Captured after pupil dilation; macula-centered; 50° FOV; camera: Kowa VX-10α; 2361x1568px: 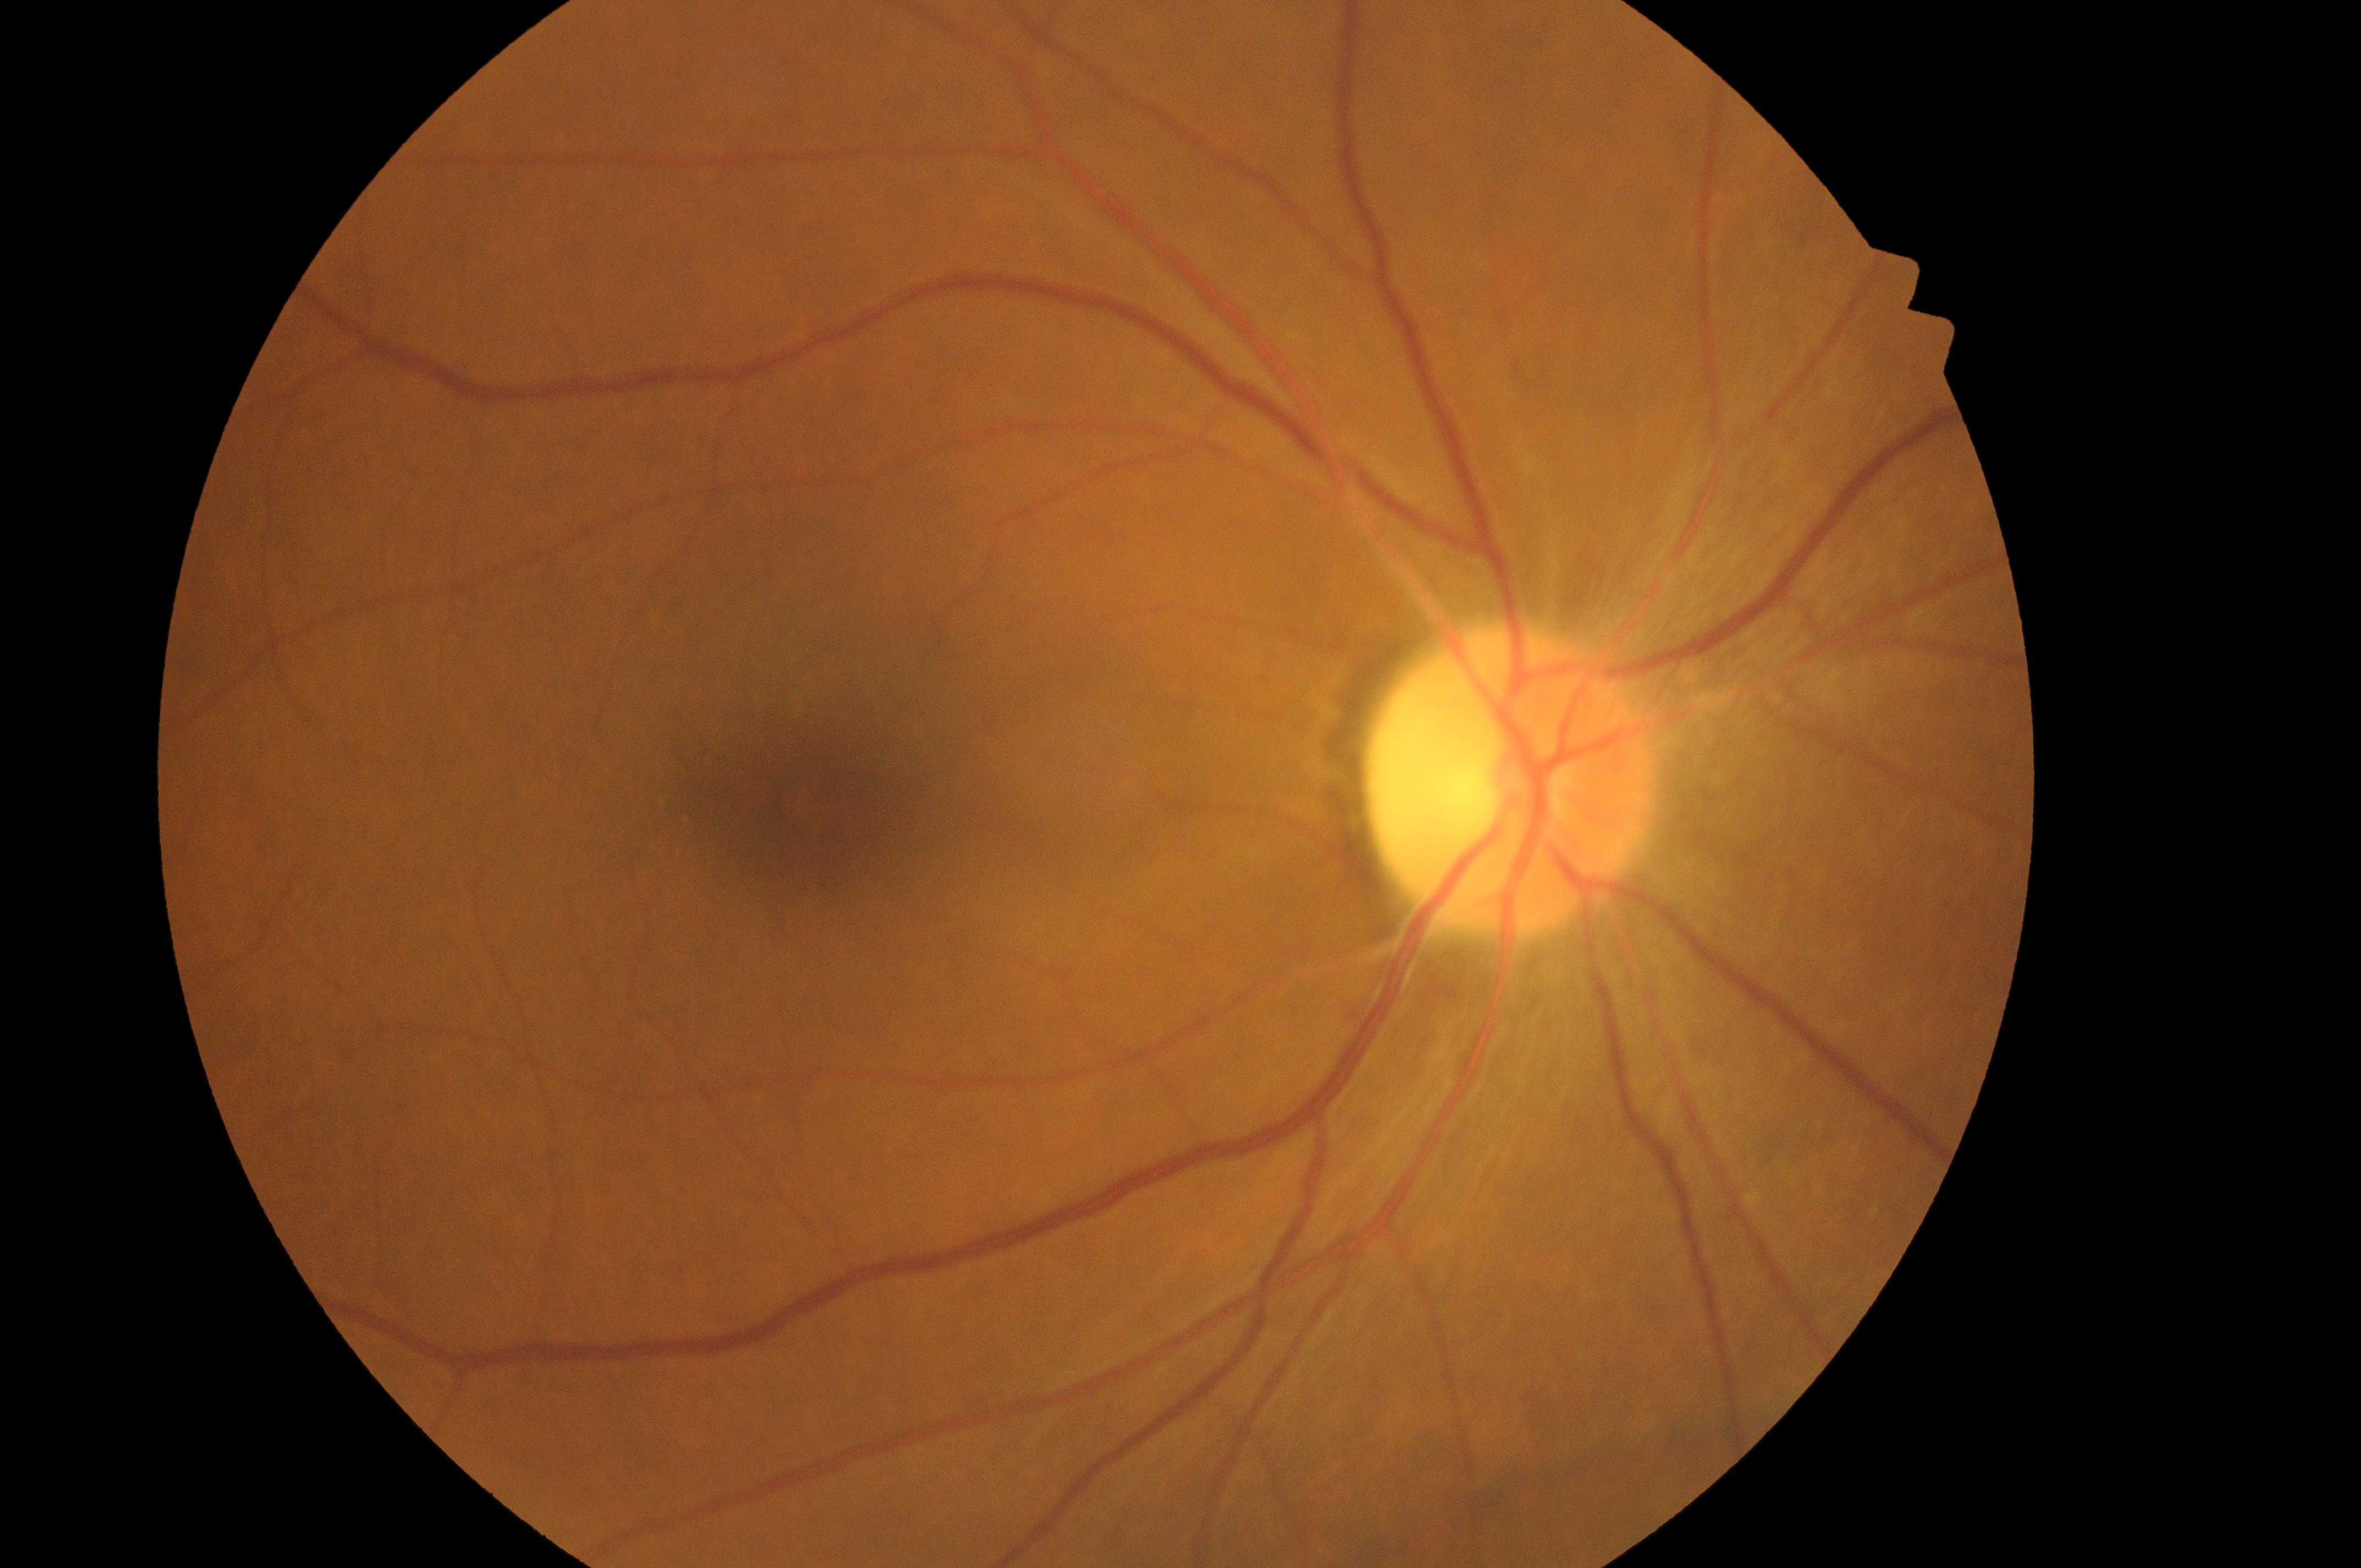

Findings:
* foveal center: x=792, y=802
* diabetic retinopathy (DR): 0 — no visible signs of diabetic retinopathy
* laterality: right eye
* diabetic macular edema (DME): grade 0 — no apparent hard exudates
* ONH: x=1502, y=785